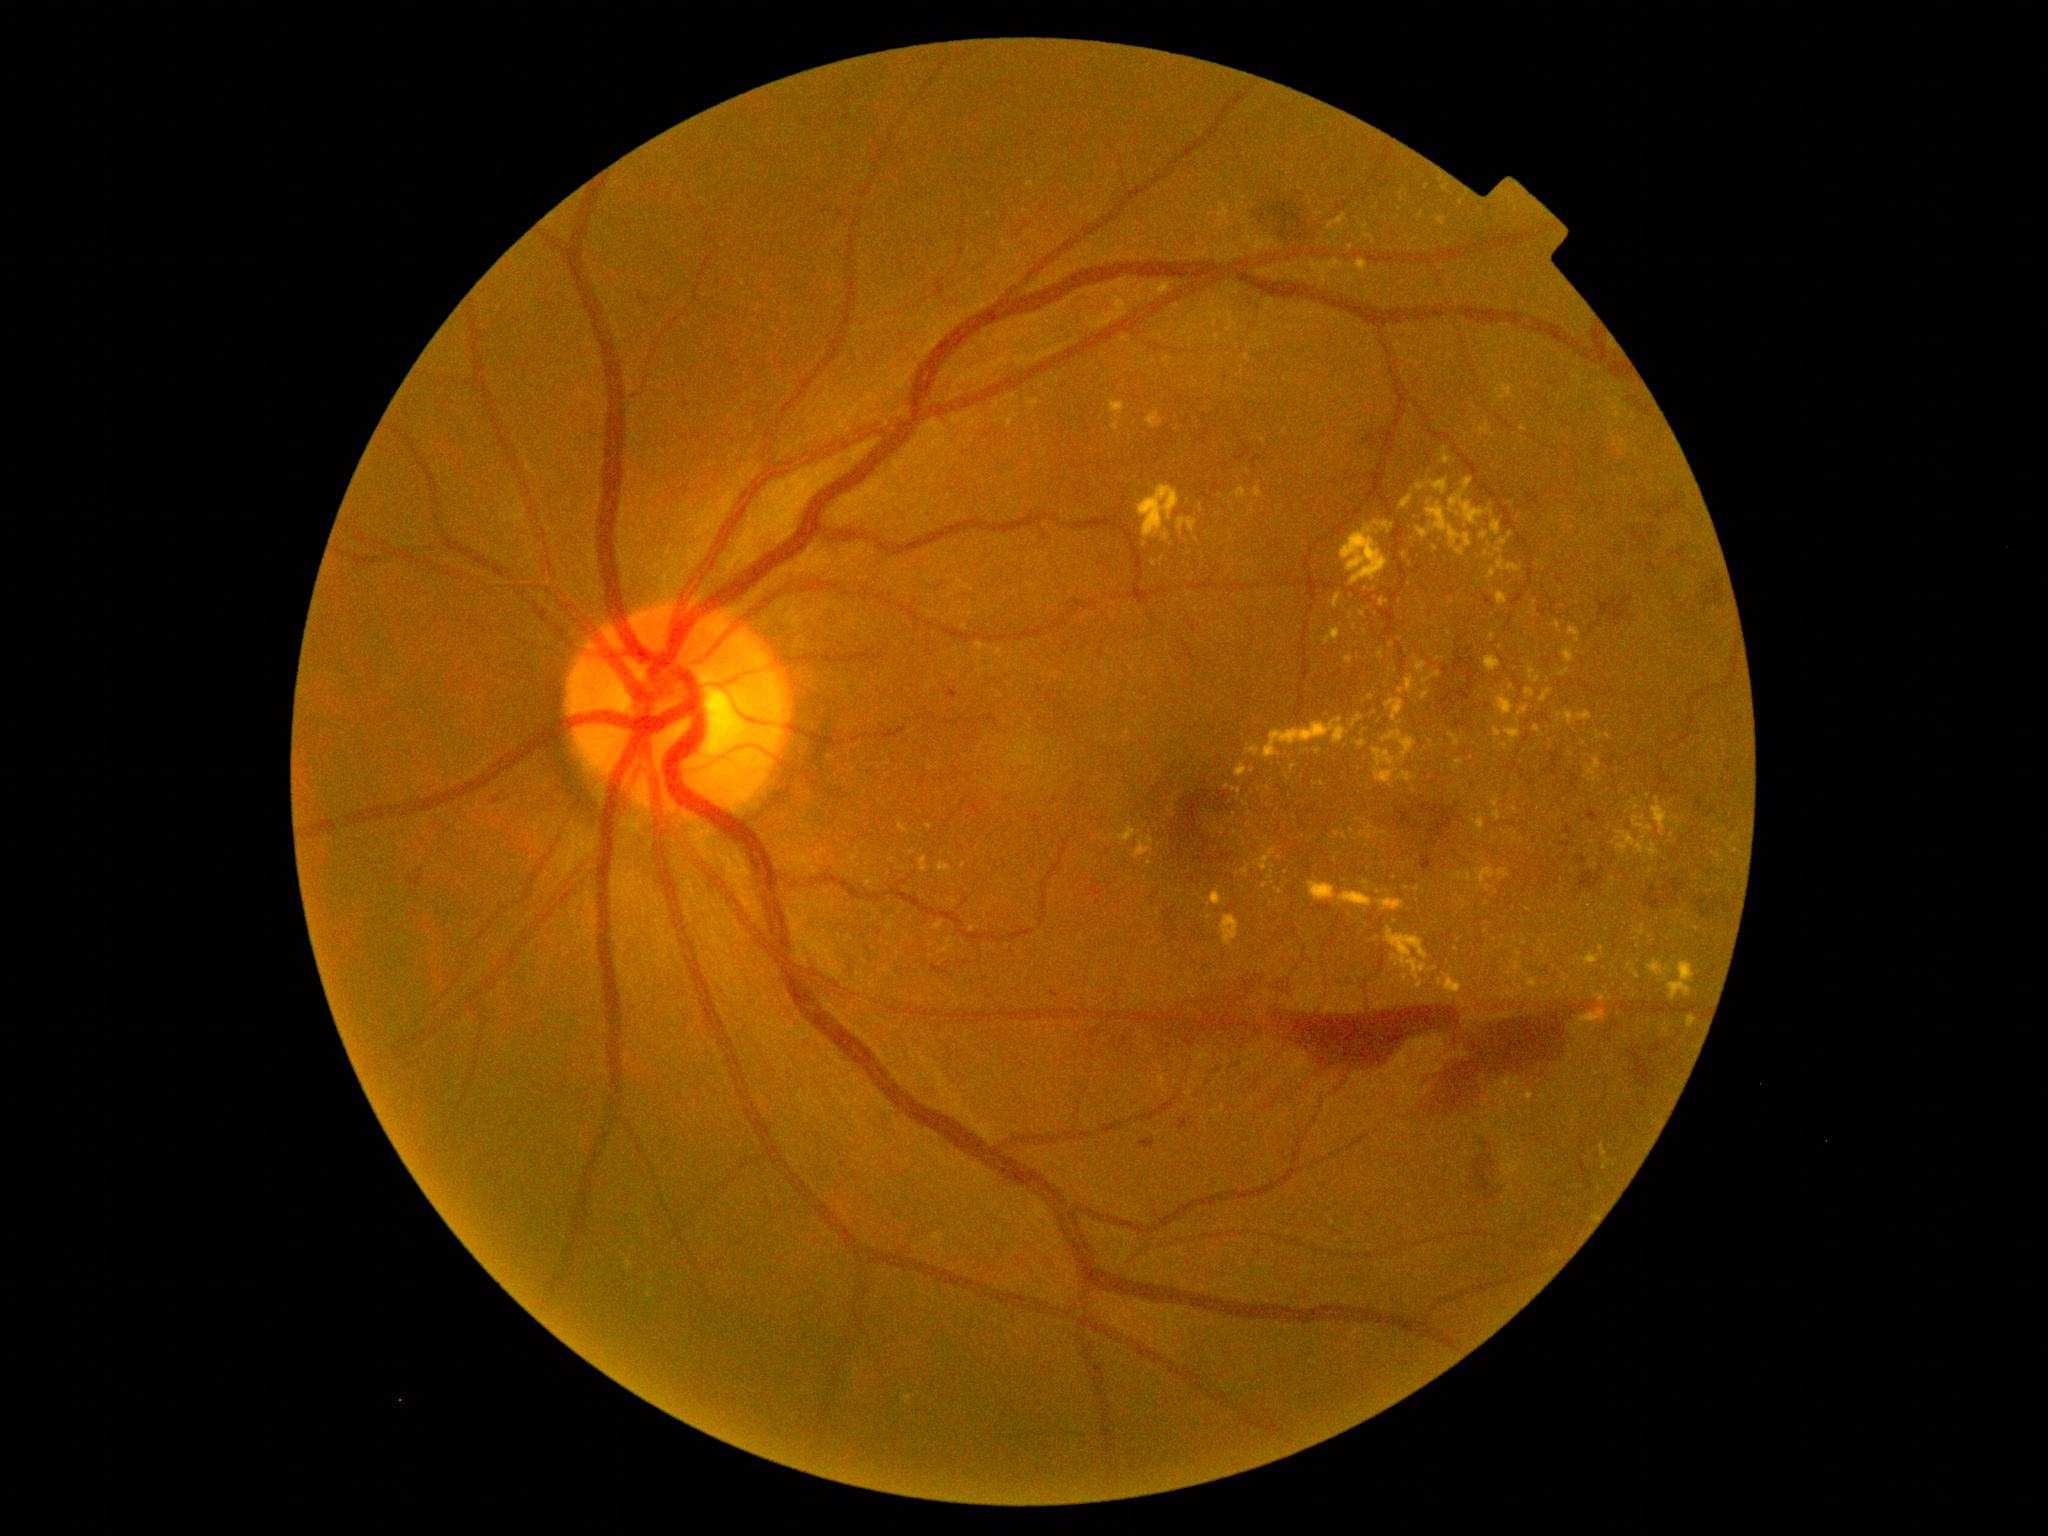
partial: true
dr_grade: 4
dr_grade_name: PDR
lesions:
  ex:
    - BBox(1450, 478, 1484, 525)
    - BBox(1373, 749, 1396, 766)
    - BBox(1633, 818, 1653, 832)
    - BBox(1401, 495, 1414, 508)
    - BBox(1227, 785, 1241, 795)
    - BBox(1162, 531, 1171, 541)
    - BBox(1255, 488, 1262, 498)
    - BBox(1228, 313, 1234, 332)
    - BBox(1345, 657, 1353, 664)
  ex_small:
    - point(1215, 316)
    - point(1505, 747)
    - point(1150, 863)
    - point(1525, 943)
    - point(1666, 1032)
    - point(930, 827)
    - point(951, 941)
    - point(1420, 985)
    - point(1362, 614)
    - point(1402, 200)